Diabetic retinopathy graded by the modified Davis classification: 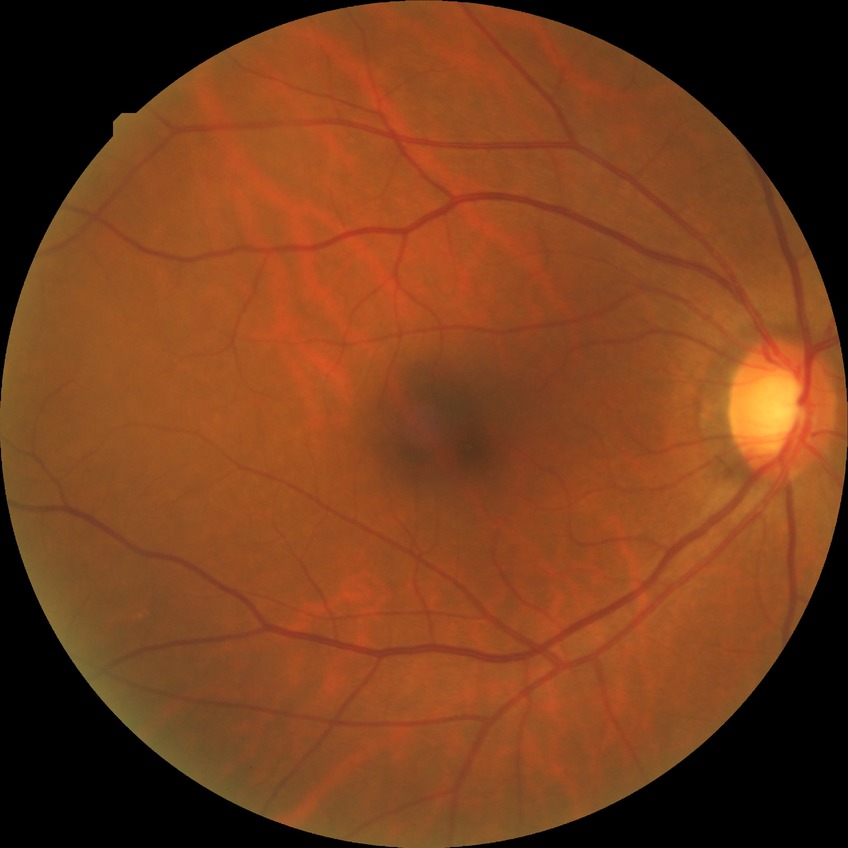
Diabetic retinopathy (DR) is no diabetic retinopathy (NDR).